Infant wide-field retinal image:
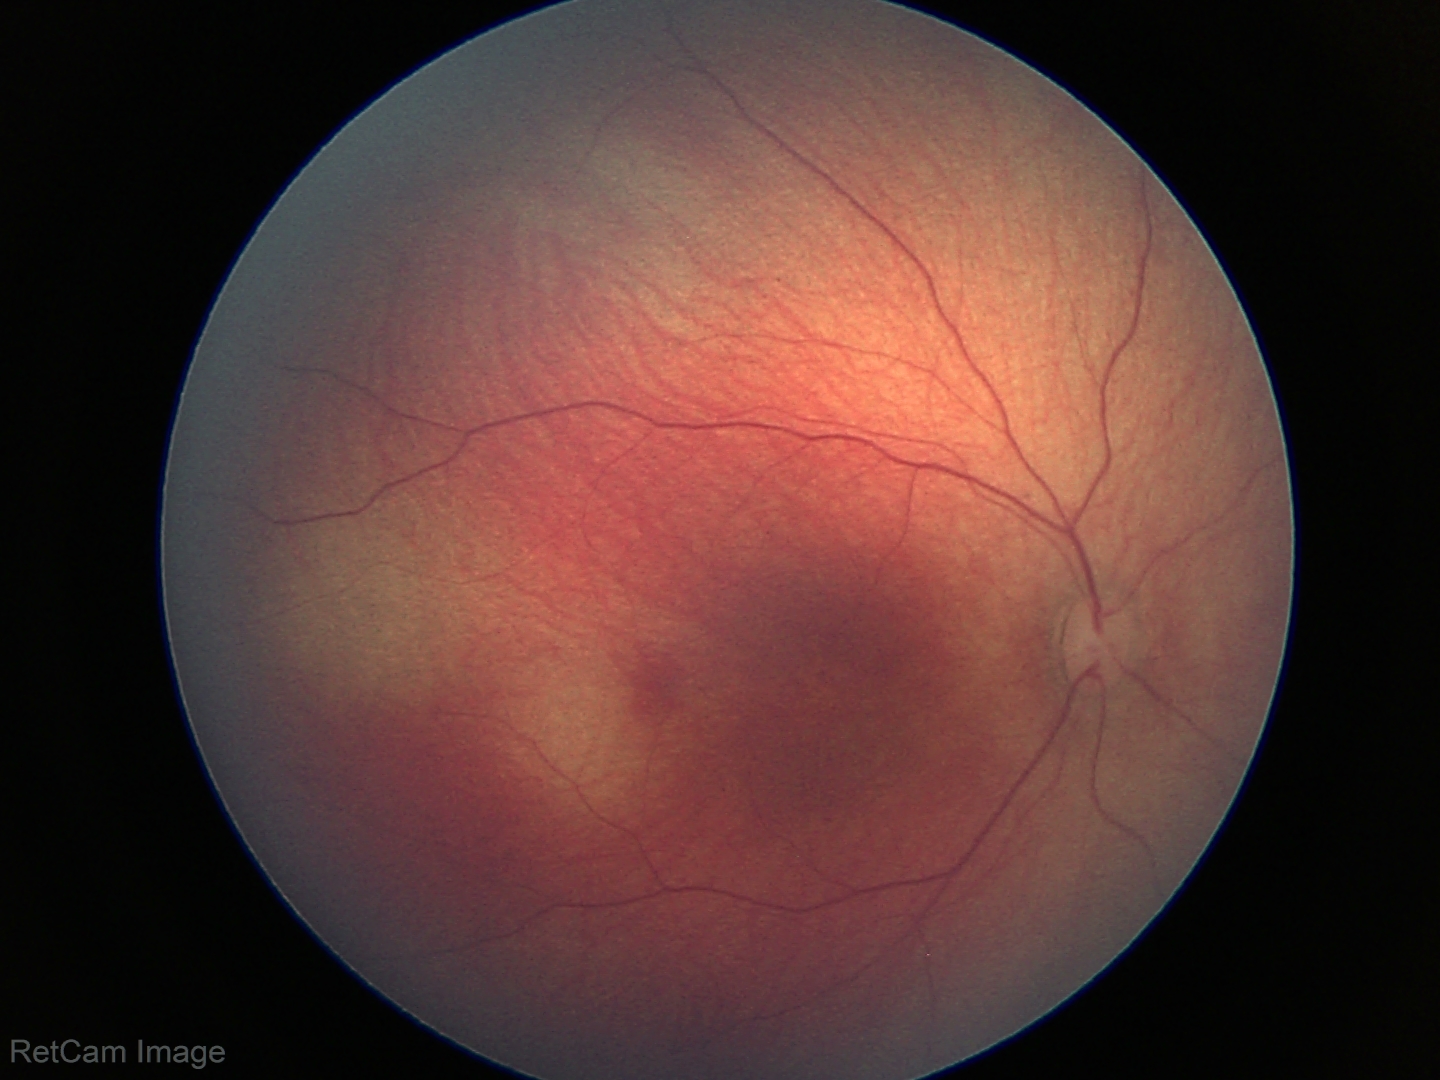
Normal screening examination.